45° FOV: 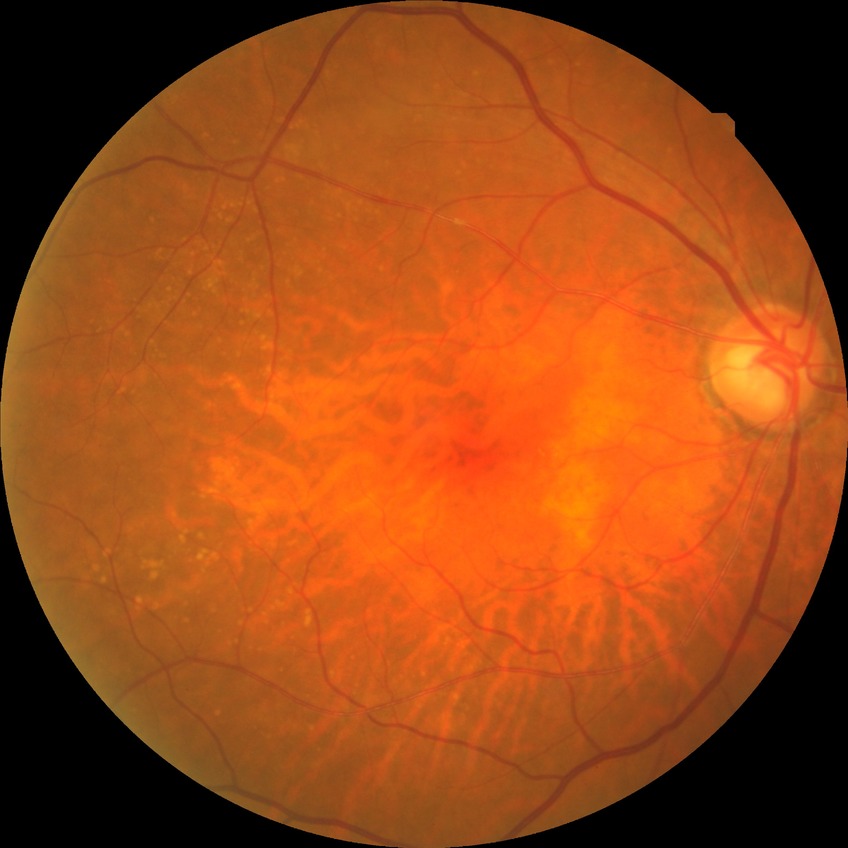

- diabetic retinopathy (DR) — NDR (no diabetic retinopathy)